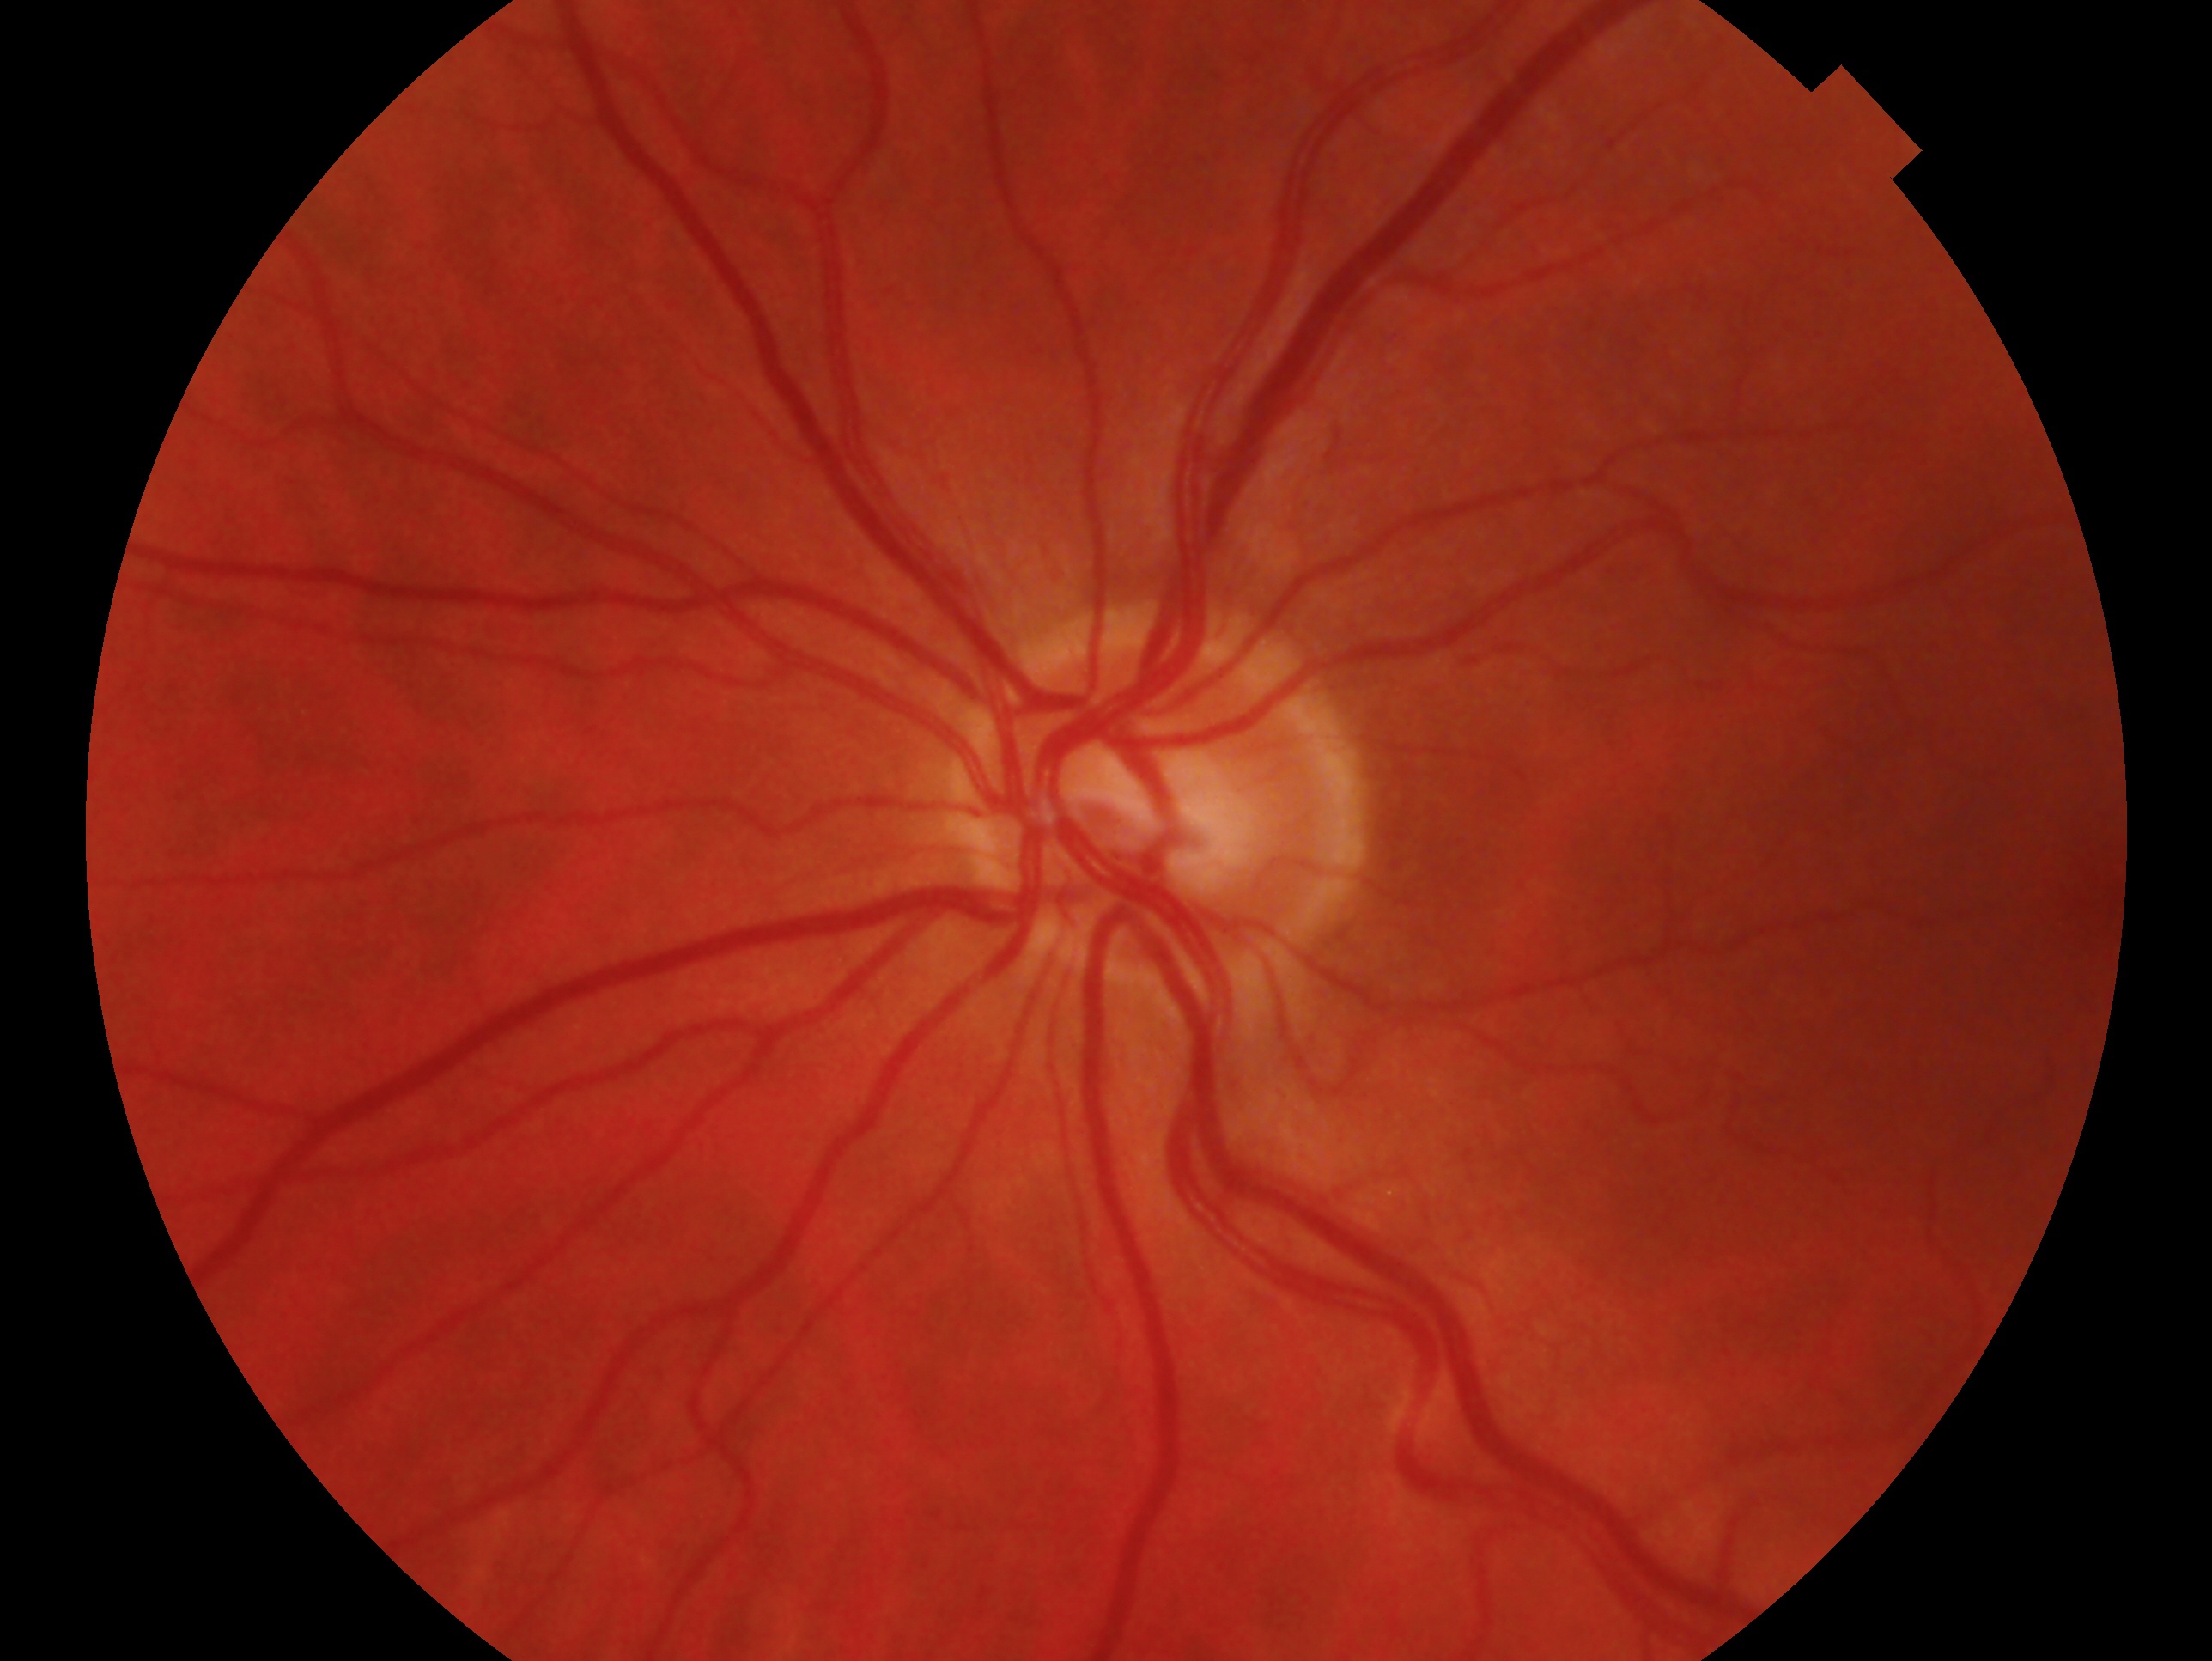

Diagnosis — no signs of glaucoma.
Eye: left.